Fundus photograph cropped around the optic nerve head.
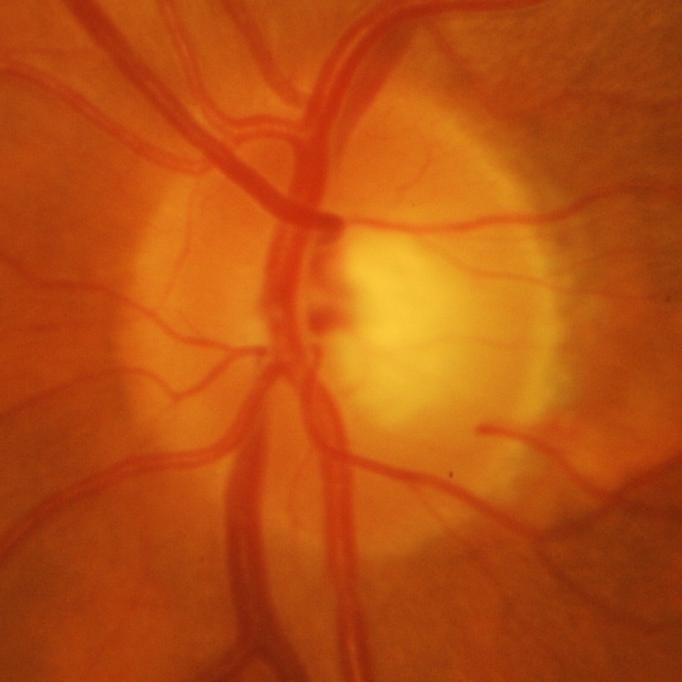
Glaucoma is present.
Glaucomatous damage to the optic nerve.